Acquired with a Remidio smartphone fundus camera. Image size 1659x2212. Retinal fundus photograph:
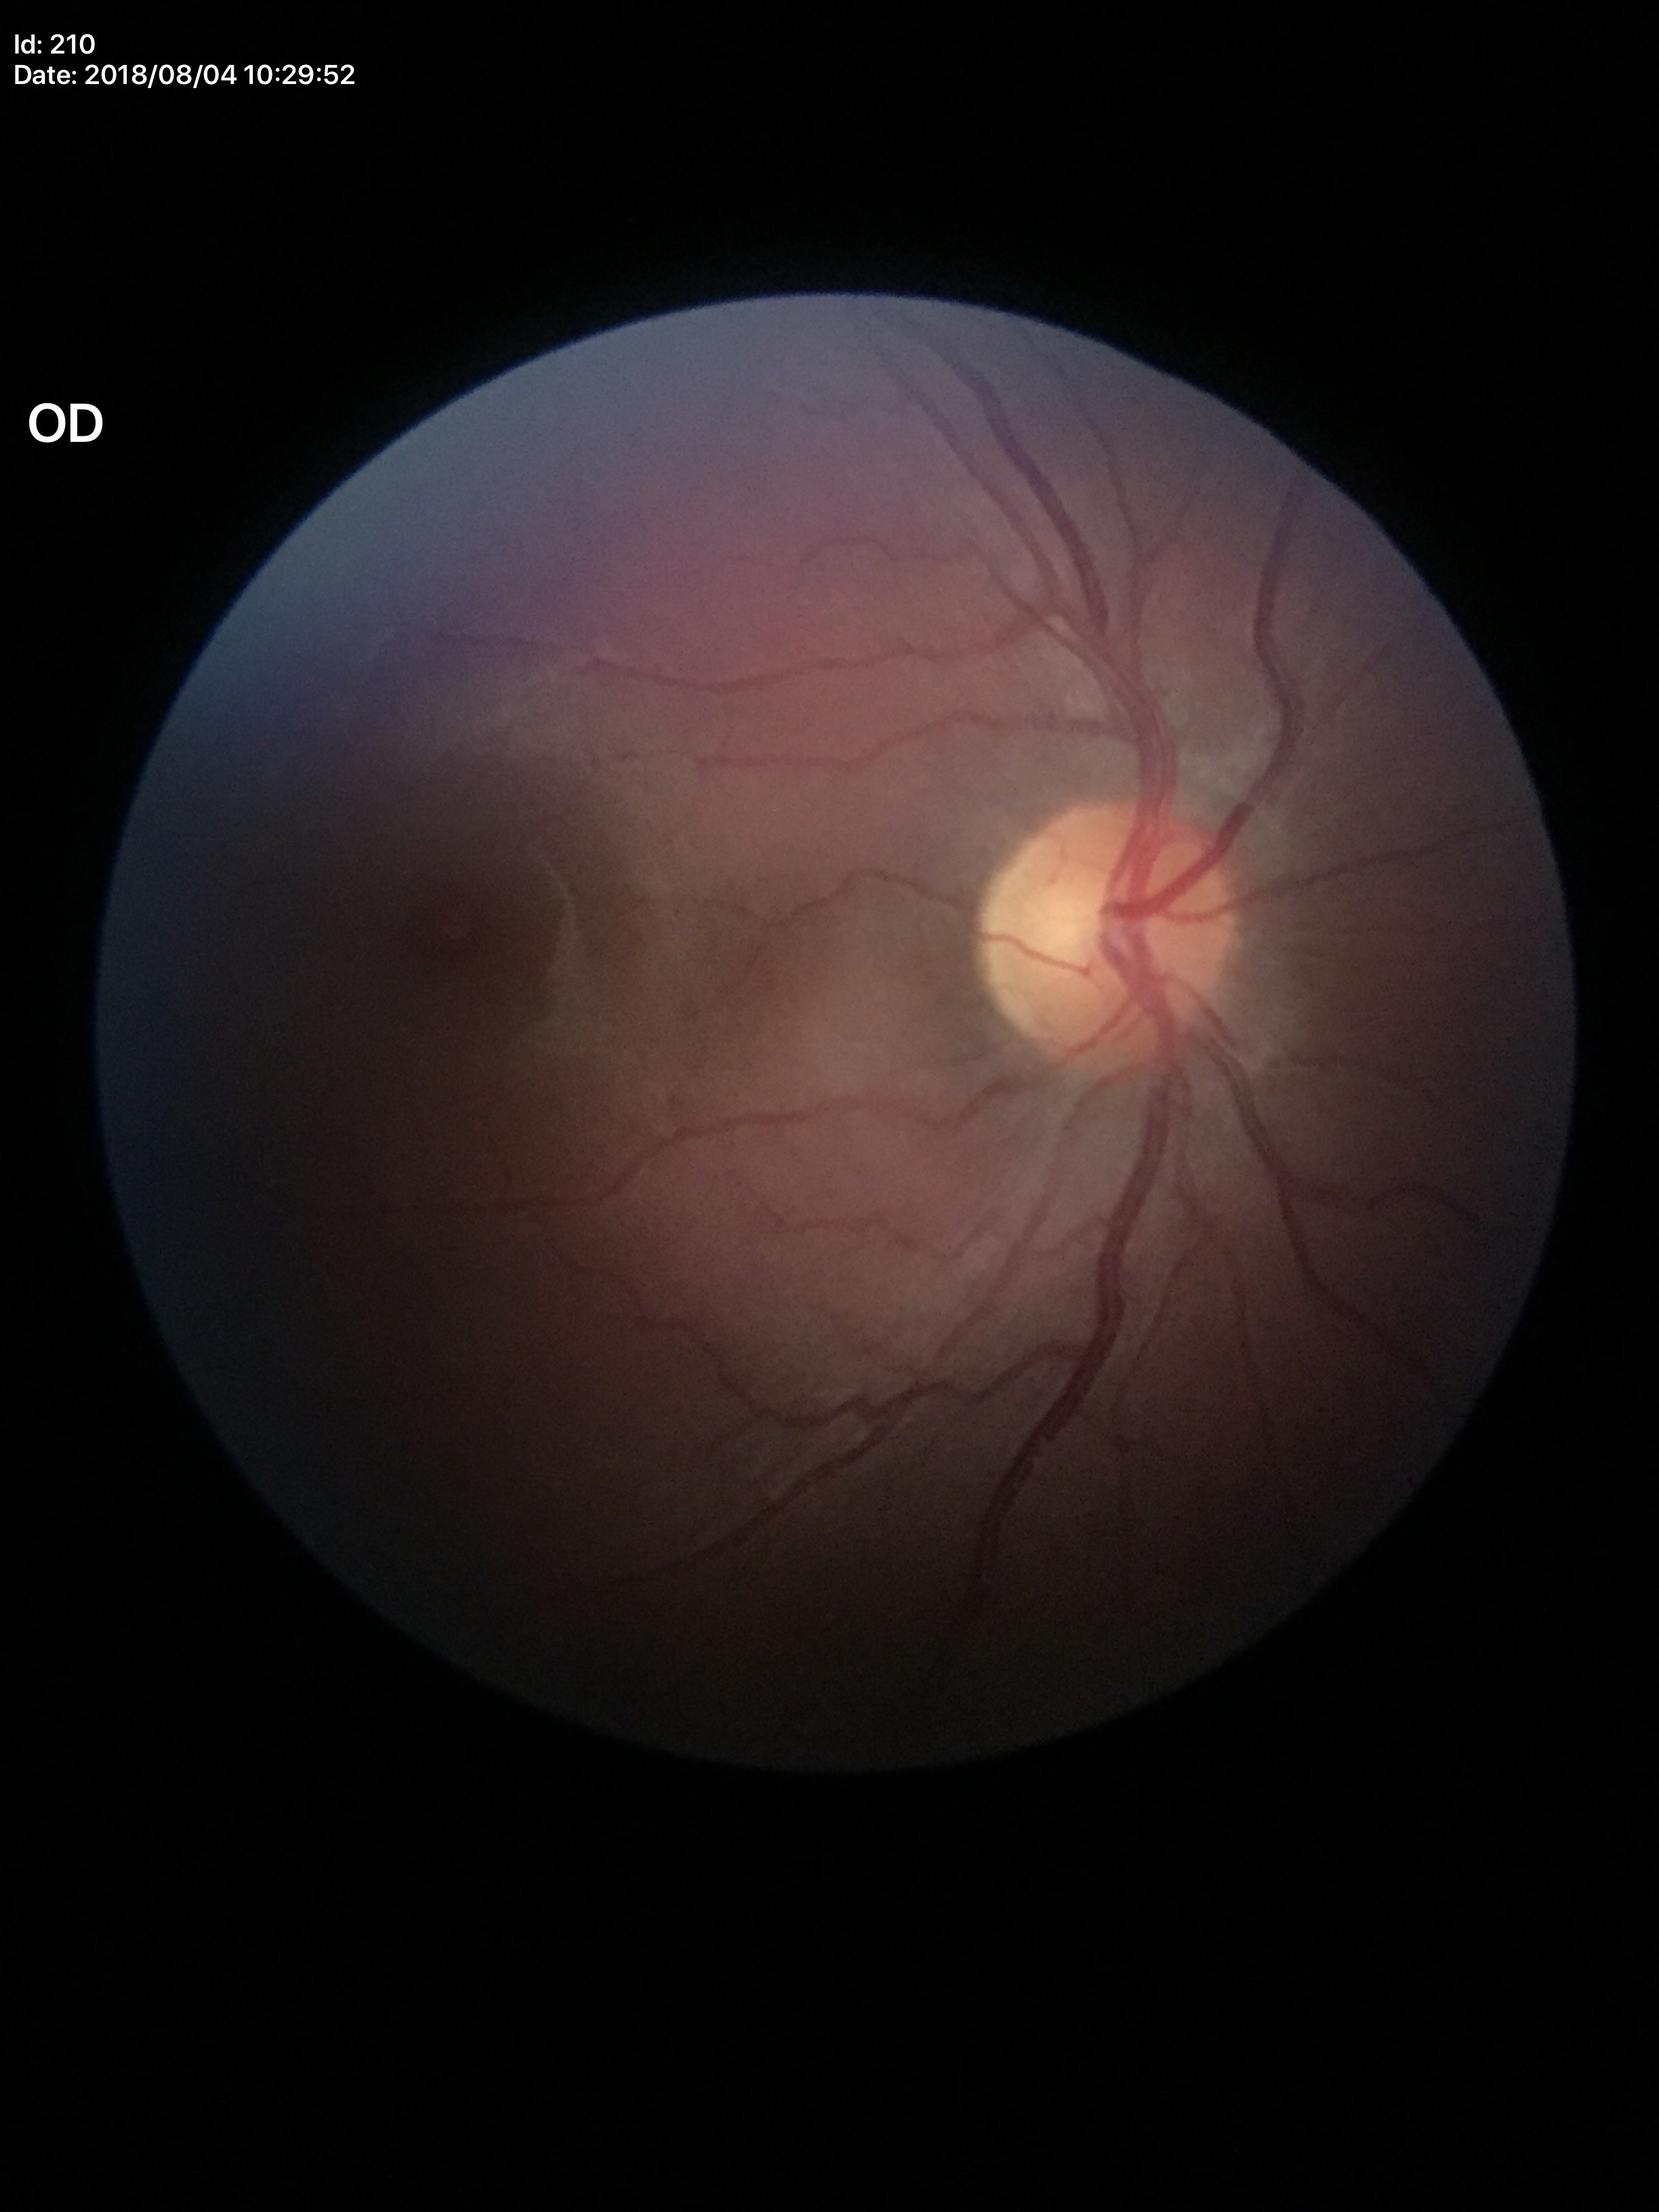
Glaucoma decision: no suspicious findings
vertical cup-to-disc ratio: 0.51
horizontal cup-to-disc ratio: 0.56